Fundus photo; 848 x 848 pixels; no pharmacologic dilation
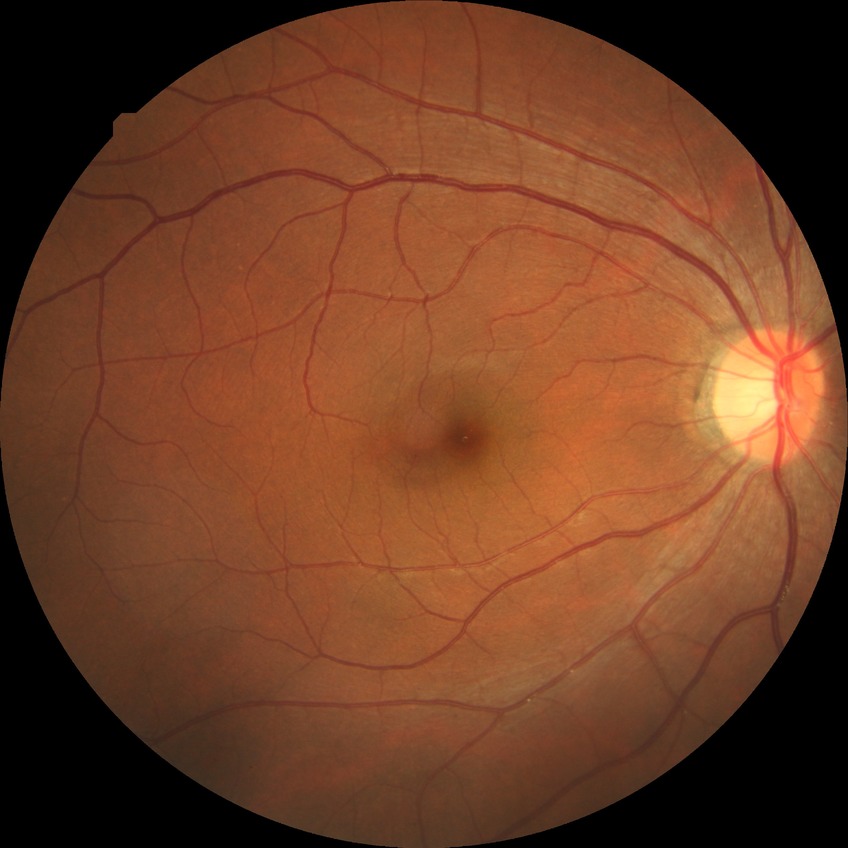
diabetic retinopathy (DR): no diabetic retinopathy (NDR).